45° field of view; 2212 x 1659 pixels; retinal fundus photograph: 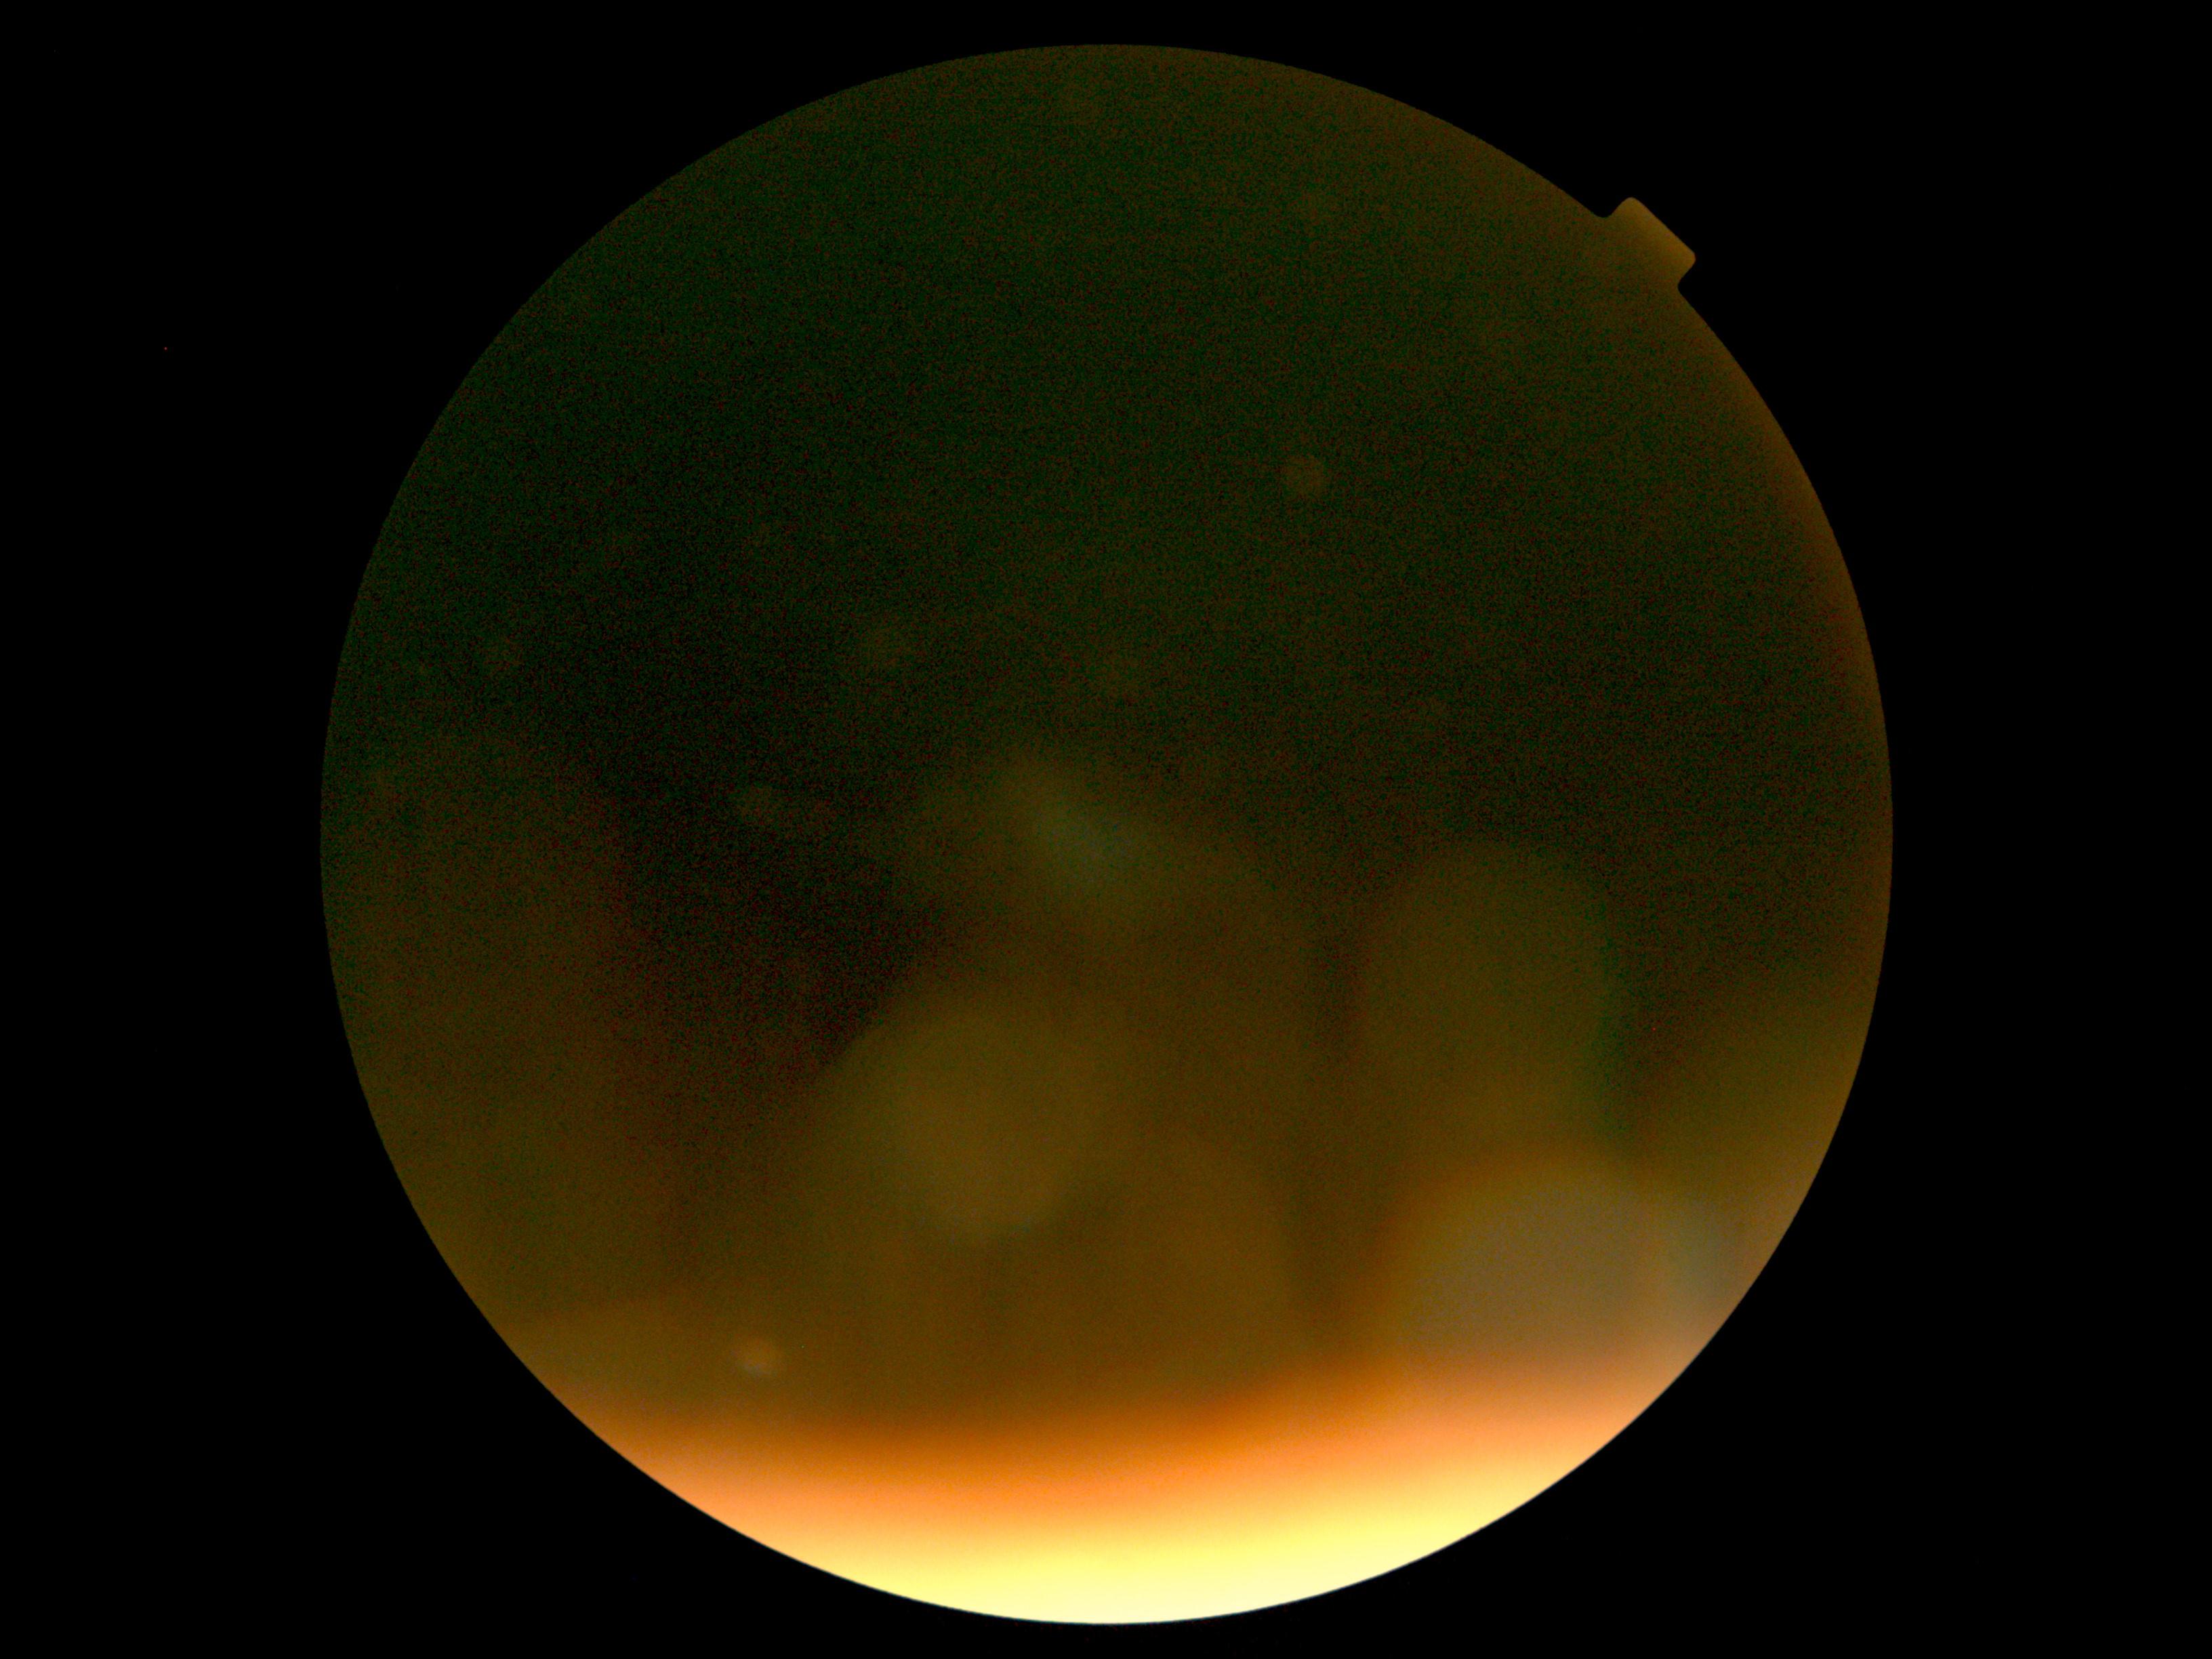

DR grade is ungradable due to poor image quality.